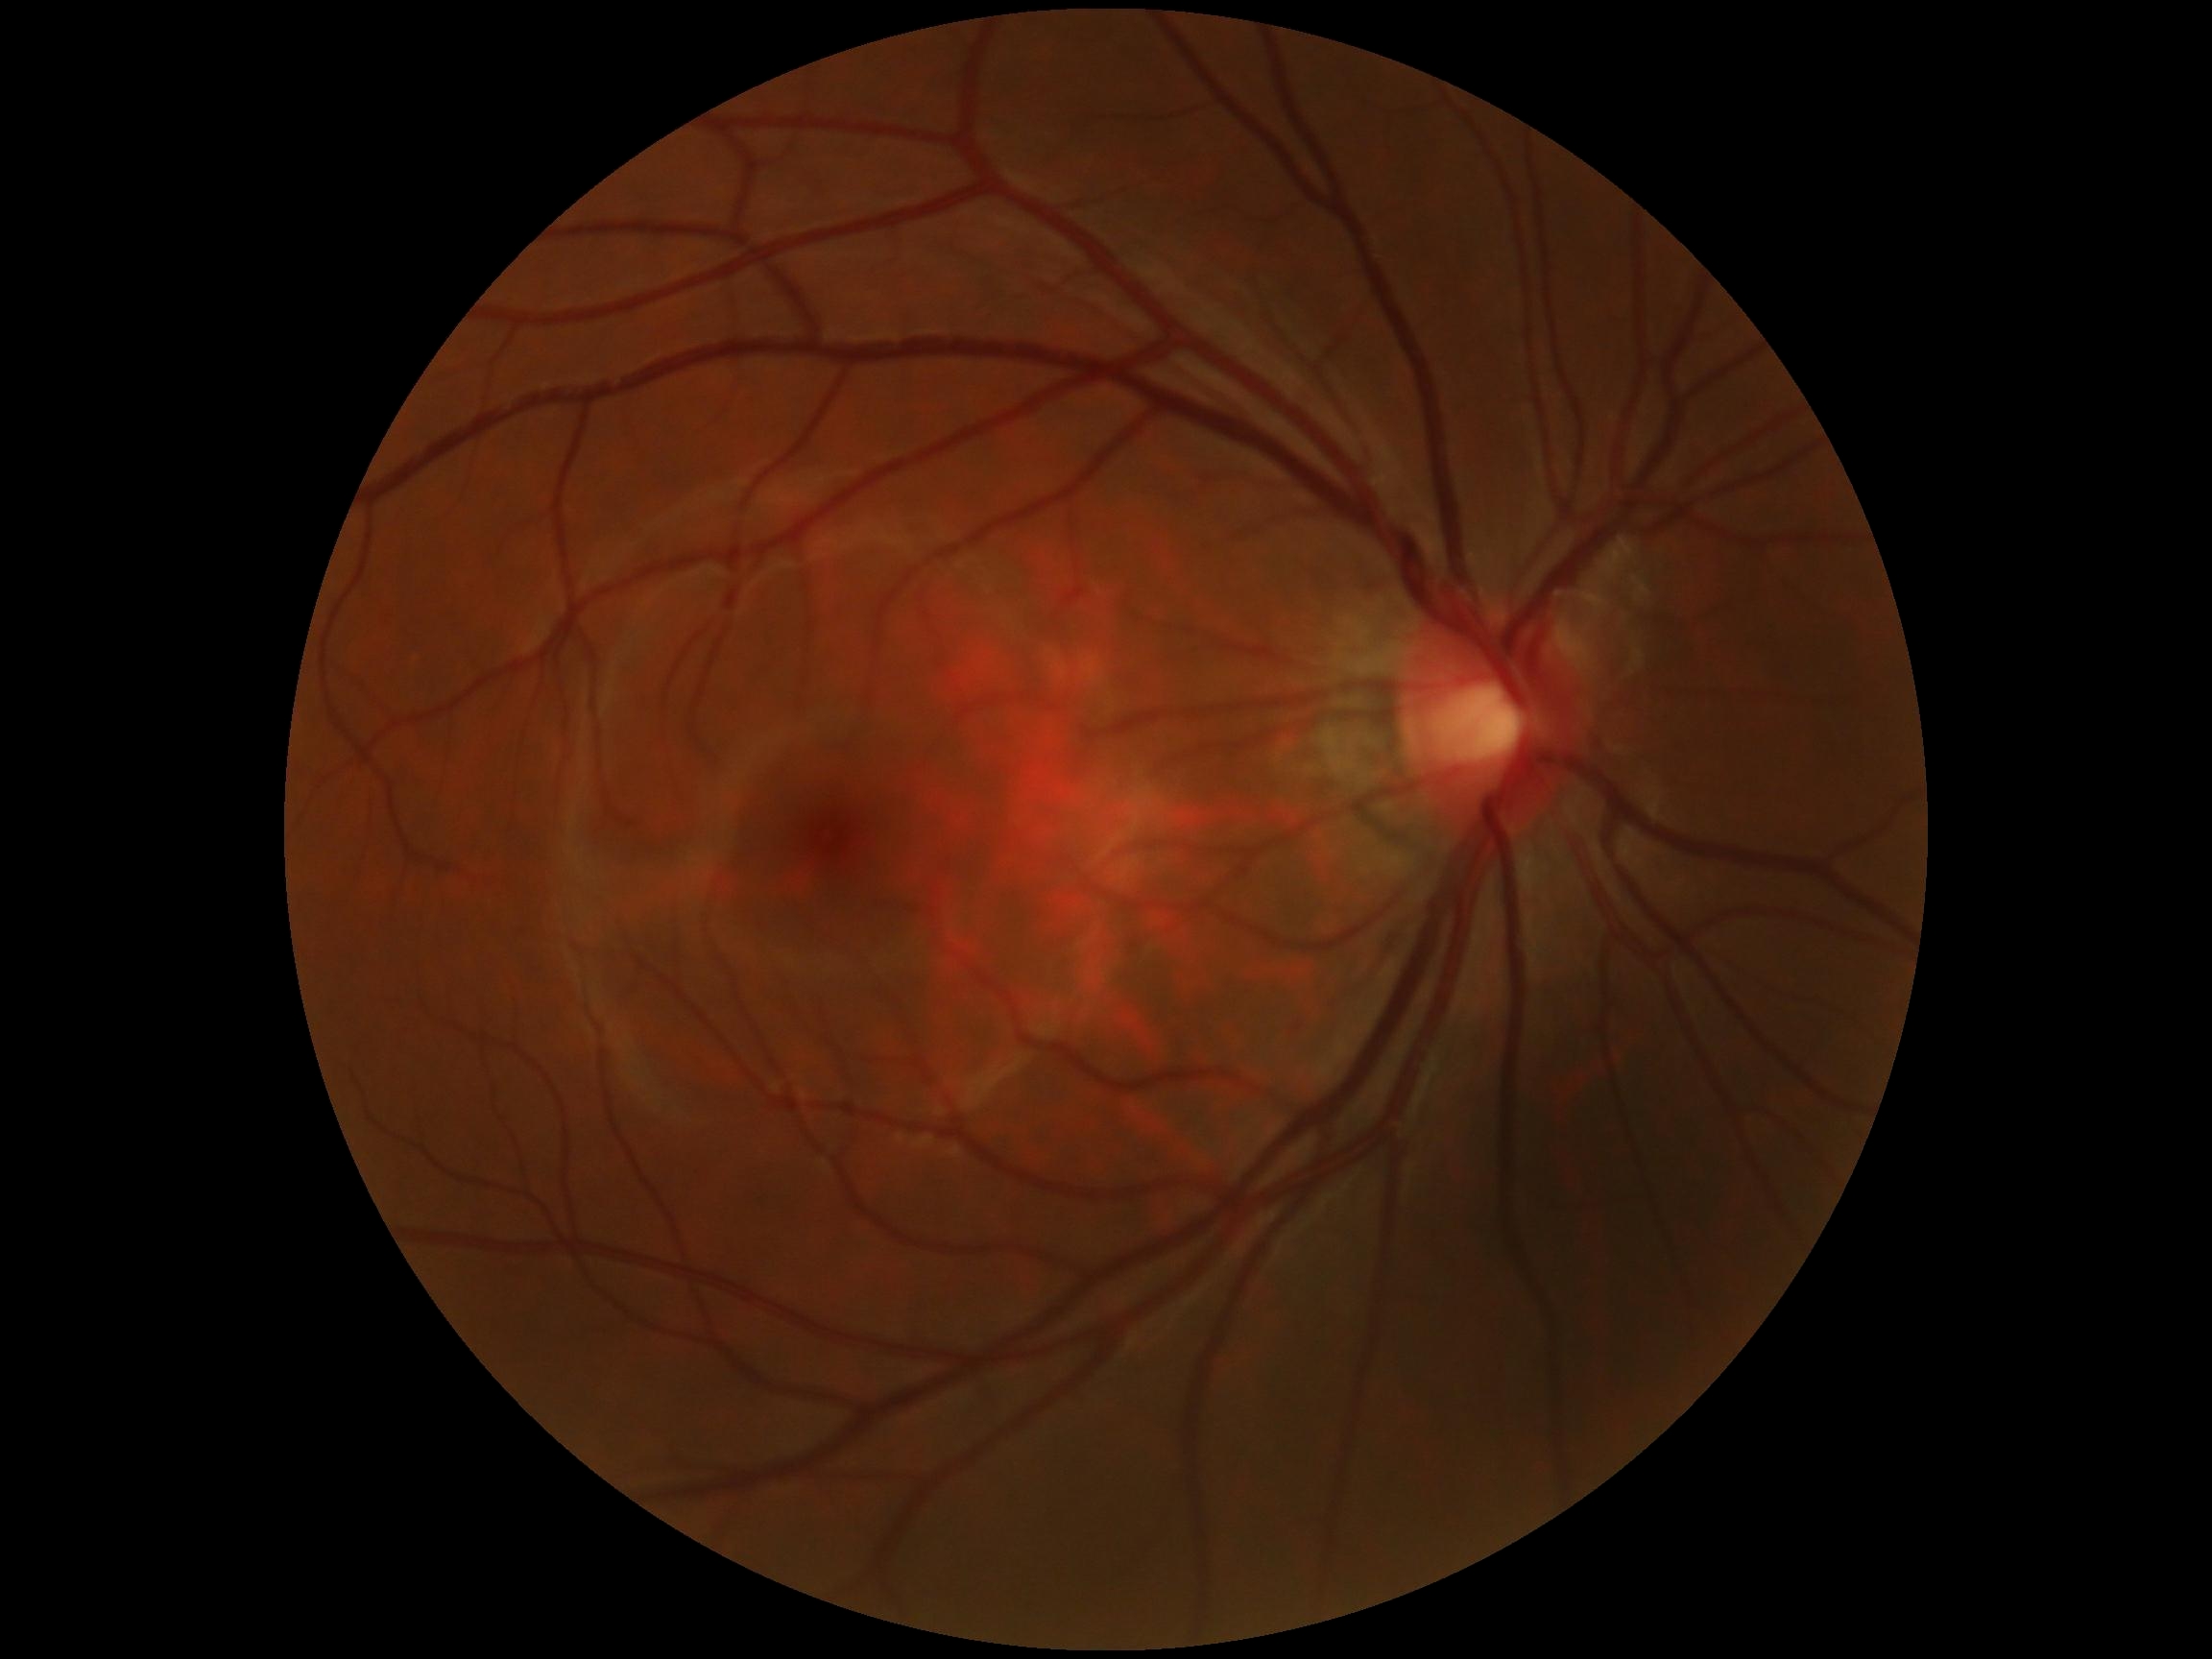
DR stage is no apparent retinopathy (grade 0) — no visible signs of diabetic retinopathy.